Retinal fundus photograph, 512 by 512 pixels: 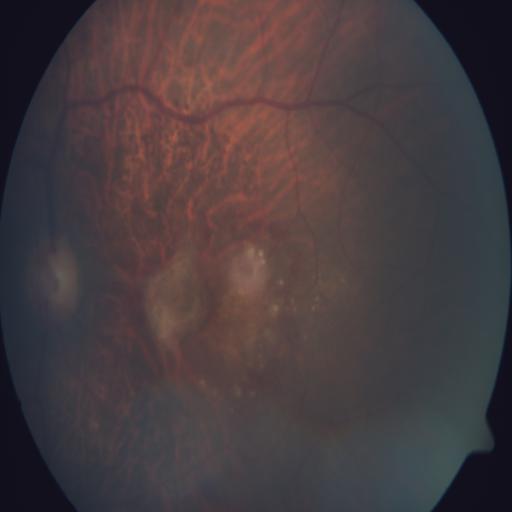 Three findings. The image shows myopia (MYA), age-related macular degeneration (ARMD) and tessellation (TSLN).